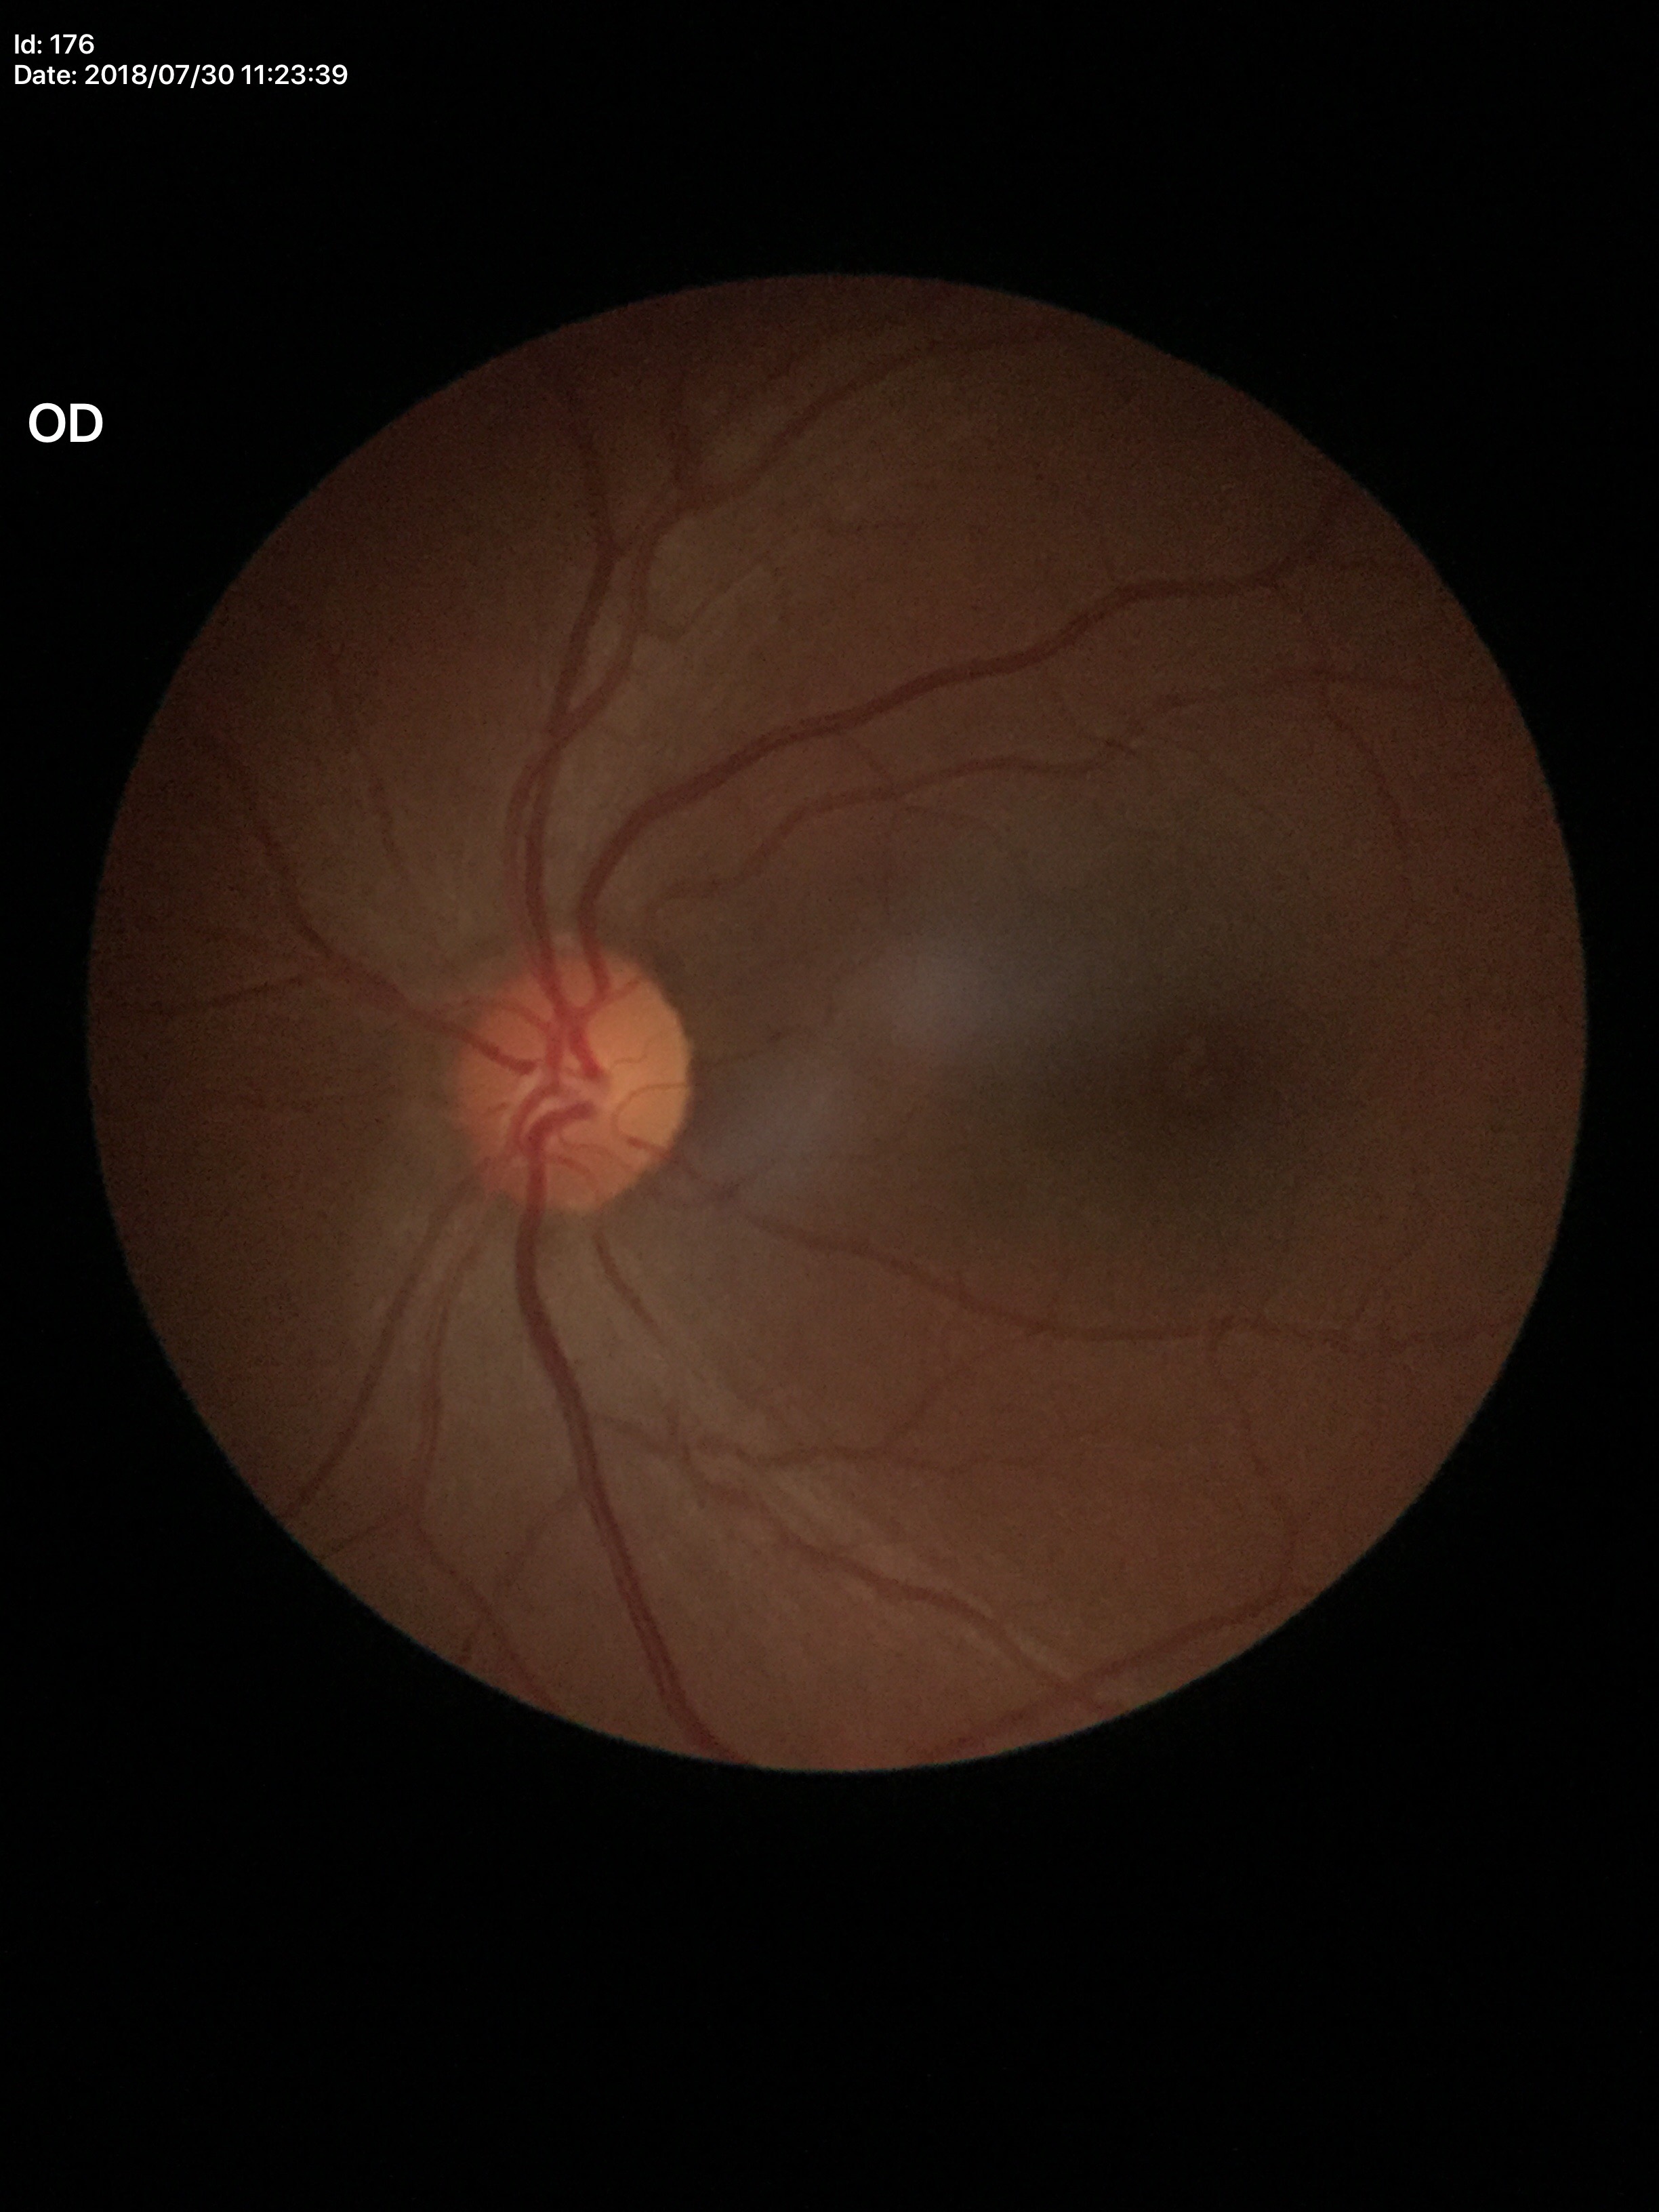 vertical cup-to-disc ratio: 0.47; Glaucoma decision: no suspicious findings